Image size 1440x1080. 130° field of view (Natus RetCam Envision). Wide-field contact fundus photograph of an infant.
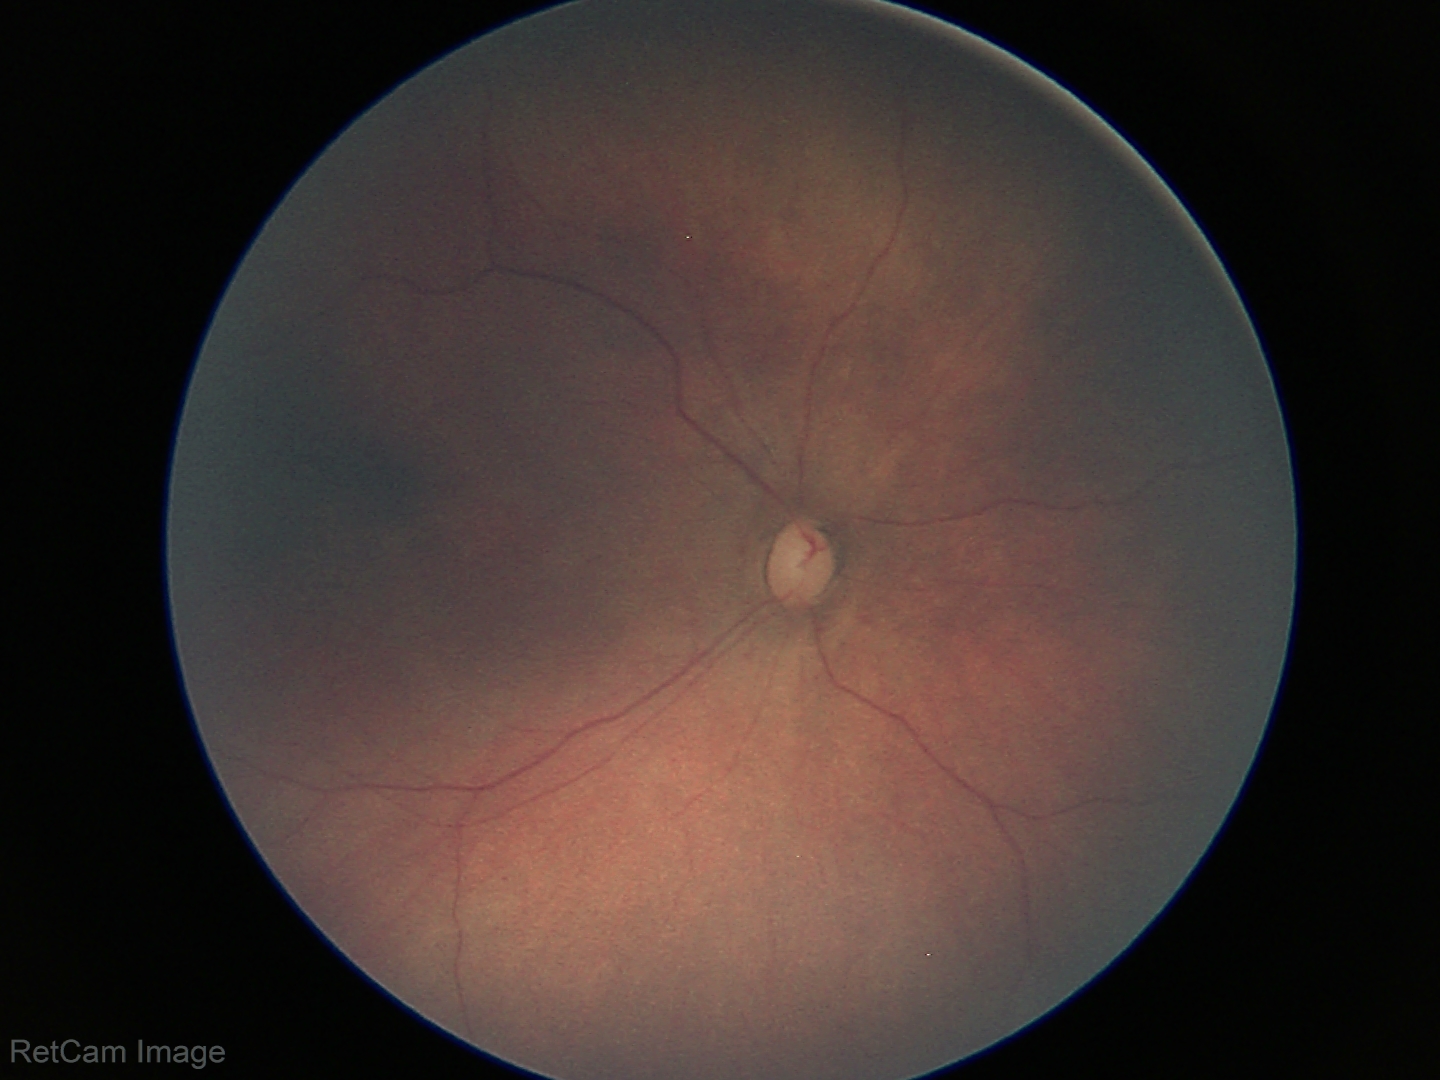

Physiological retinal appearance for postconceptual age.